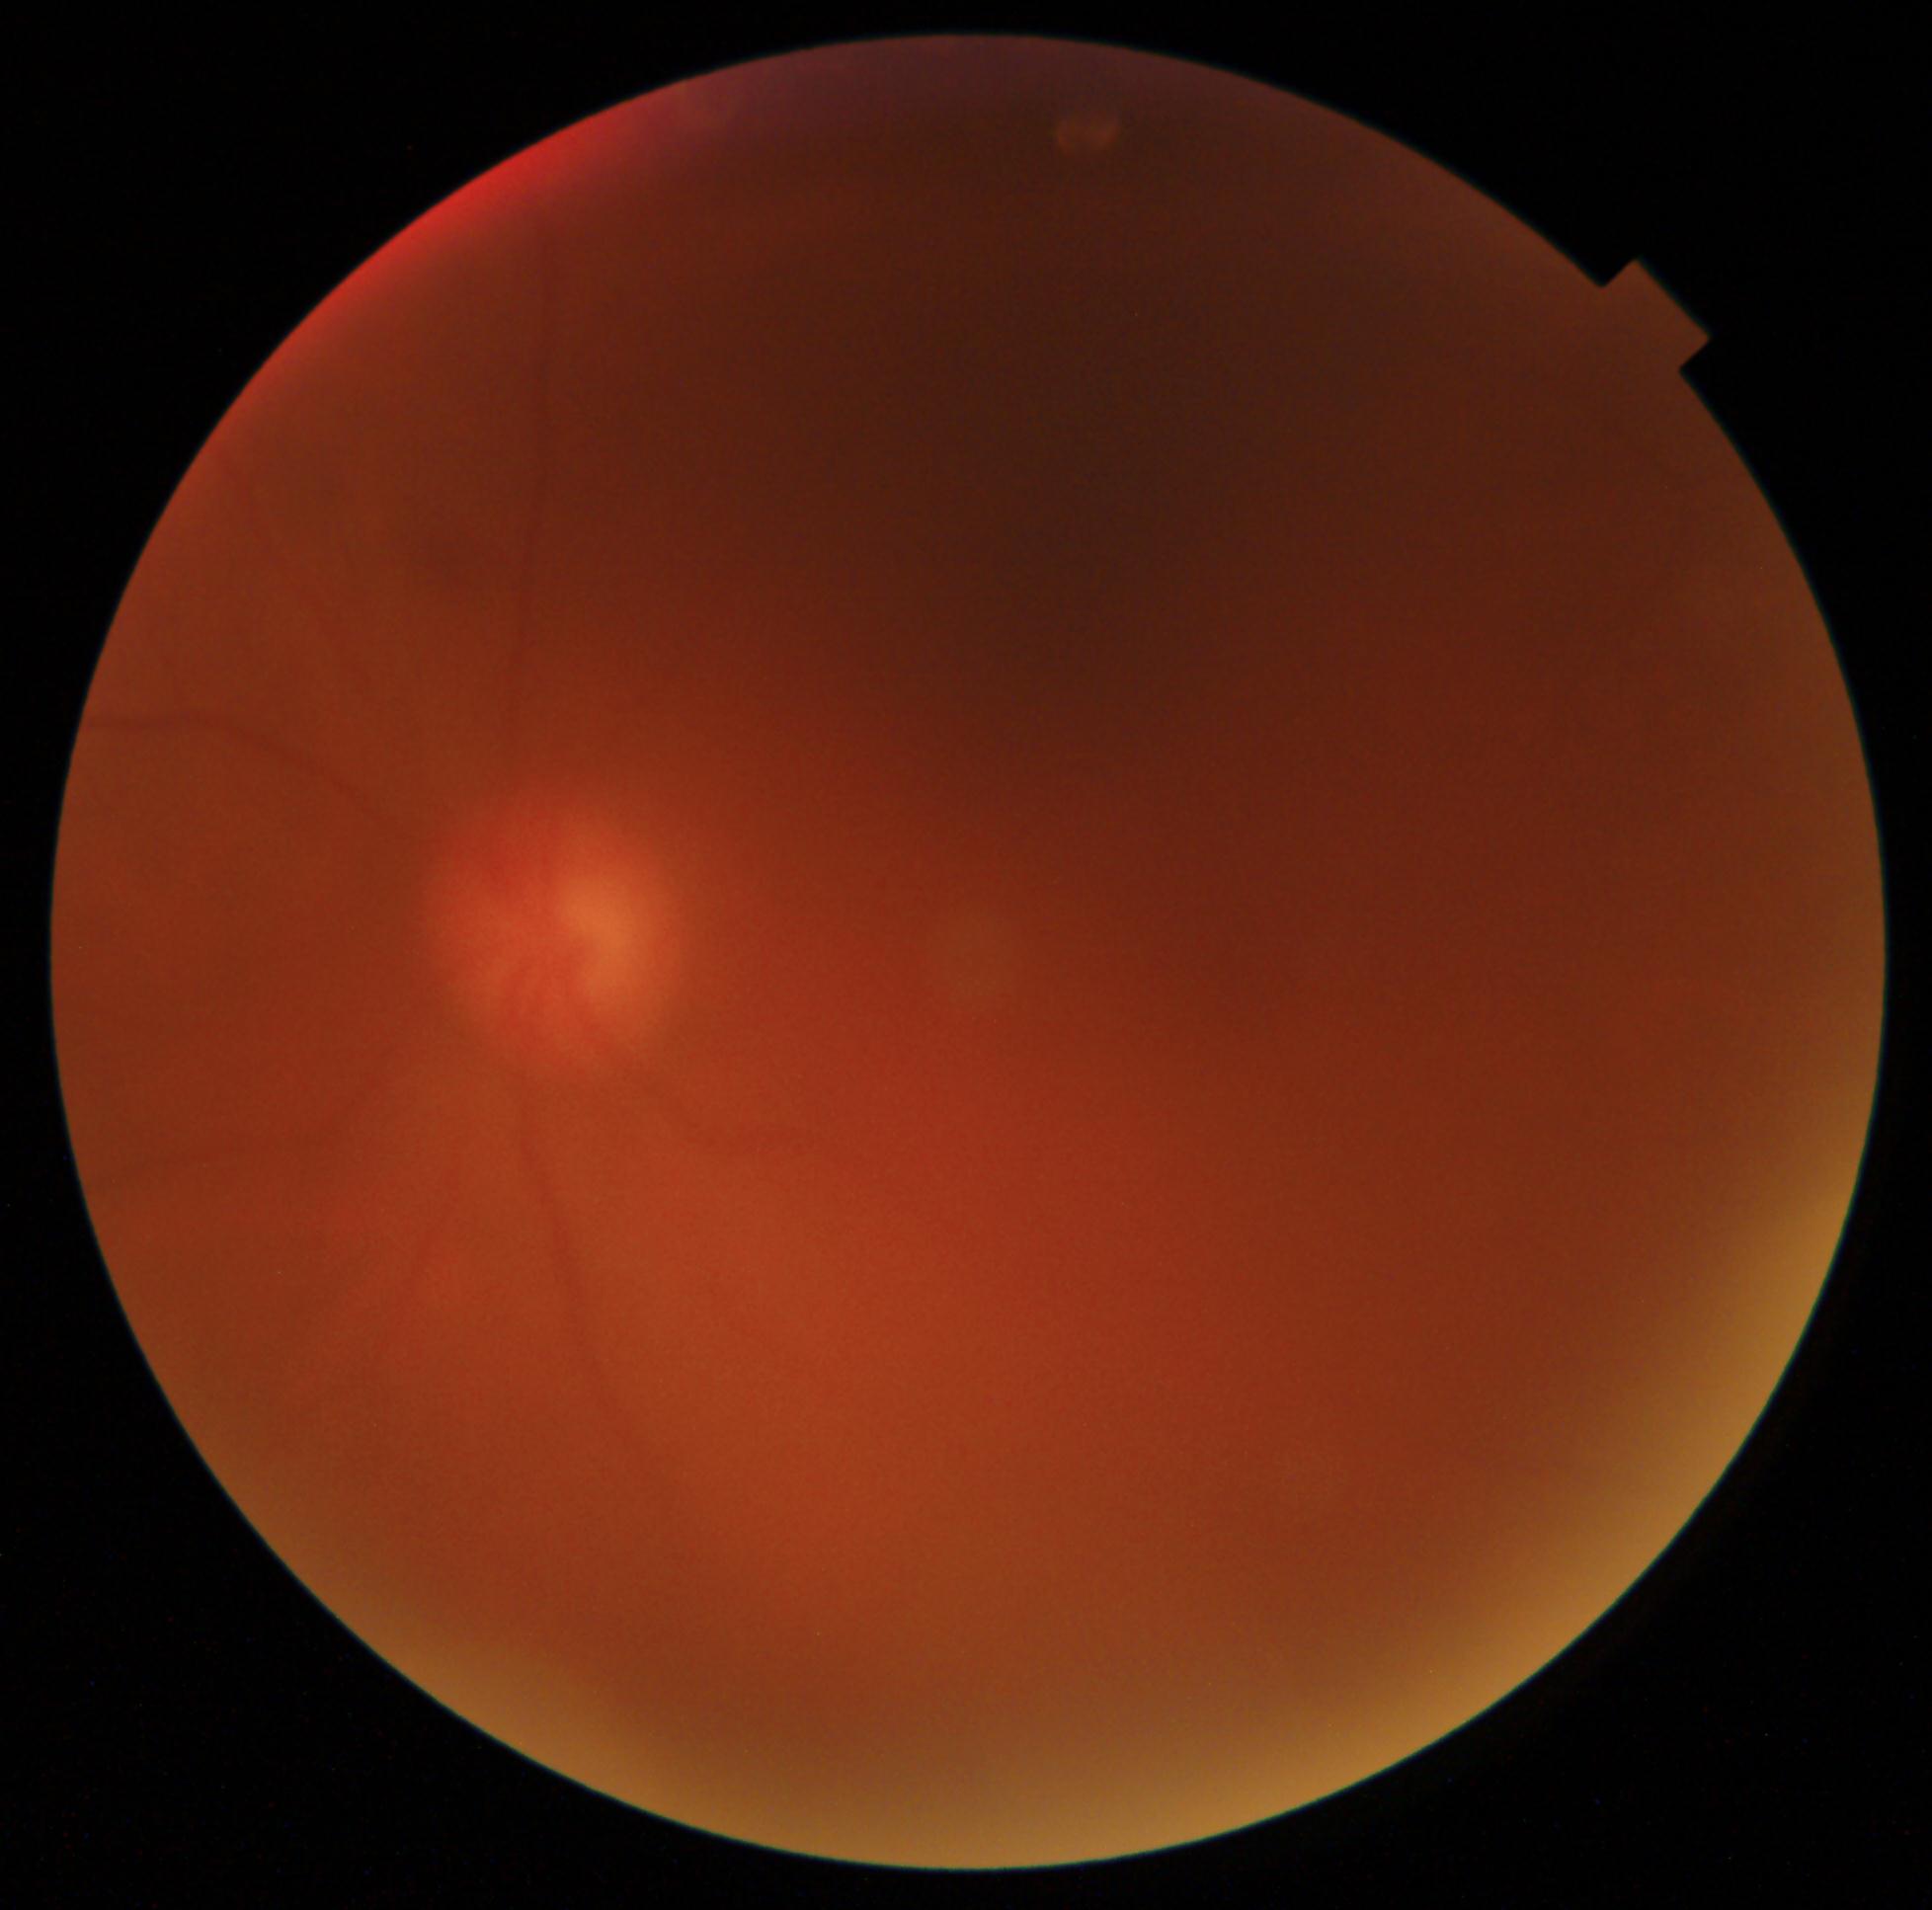

DR stage: ungradable
image quality: insufficient